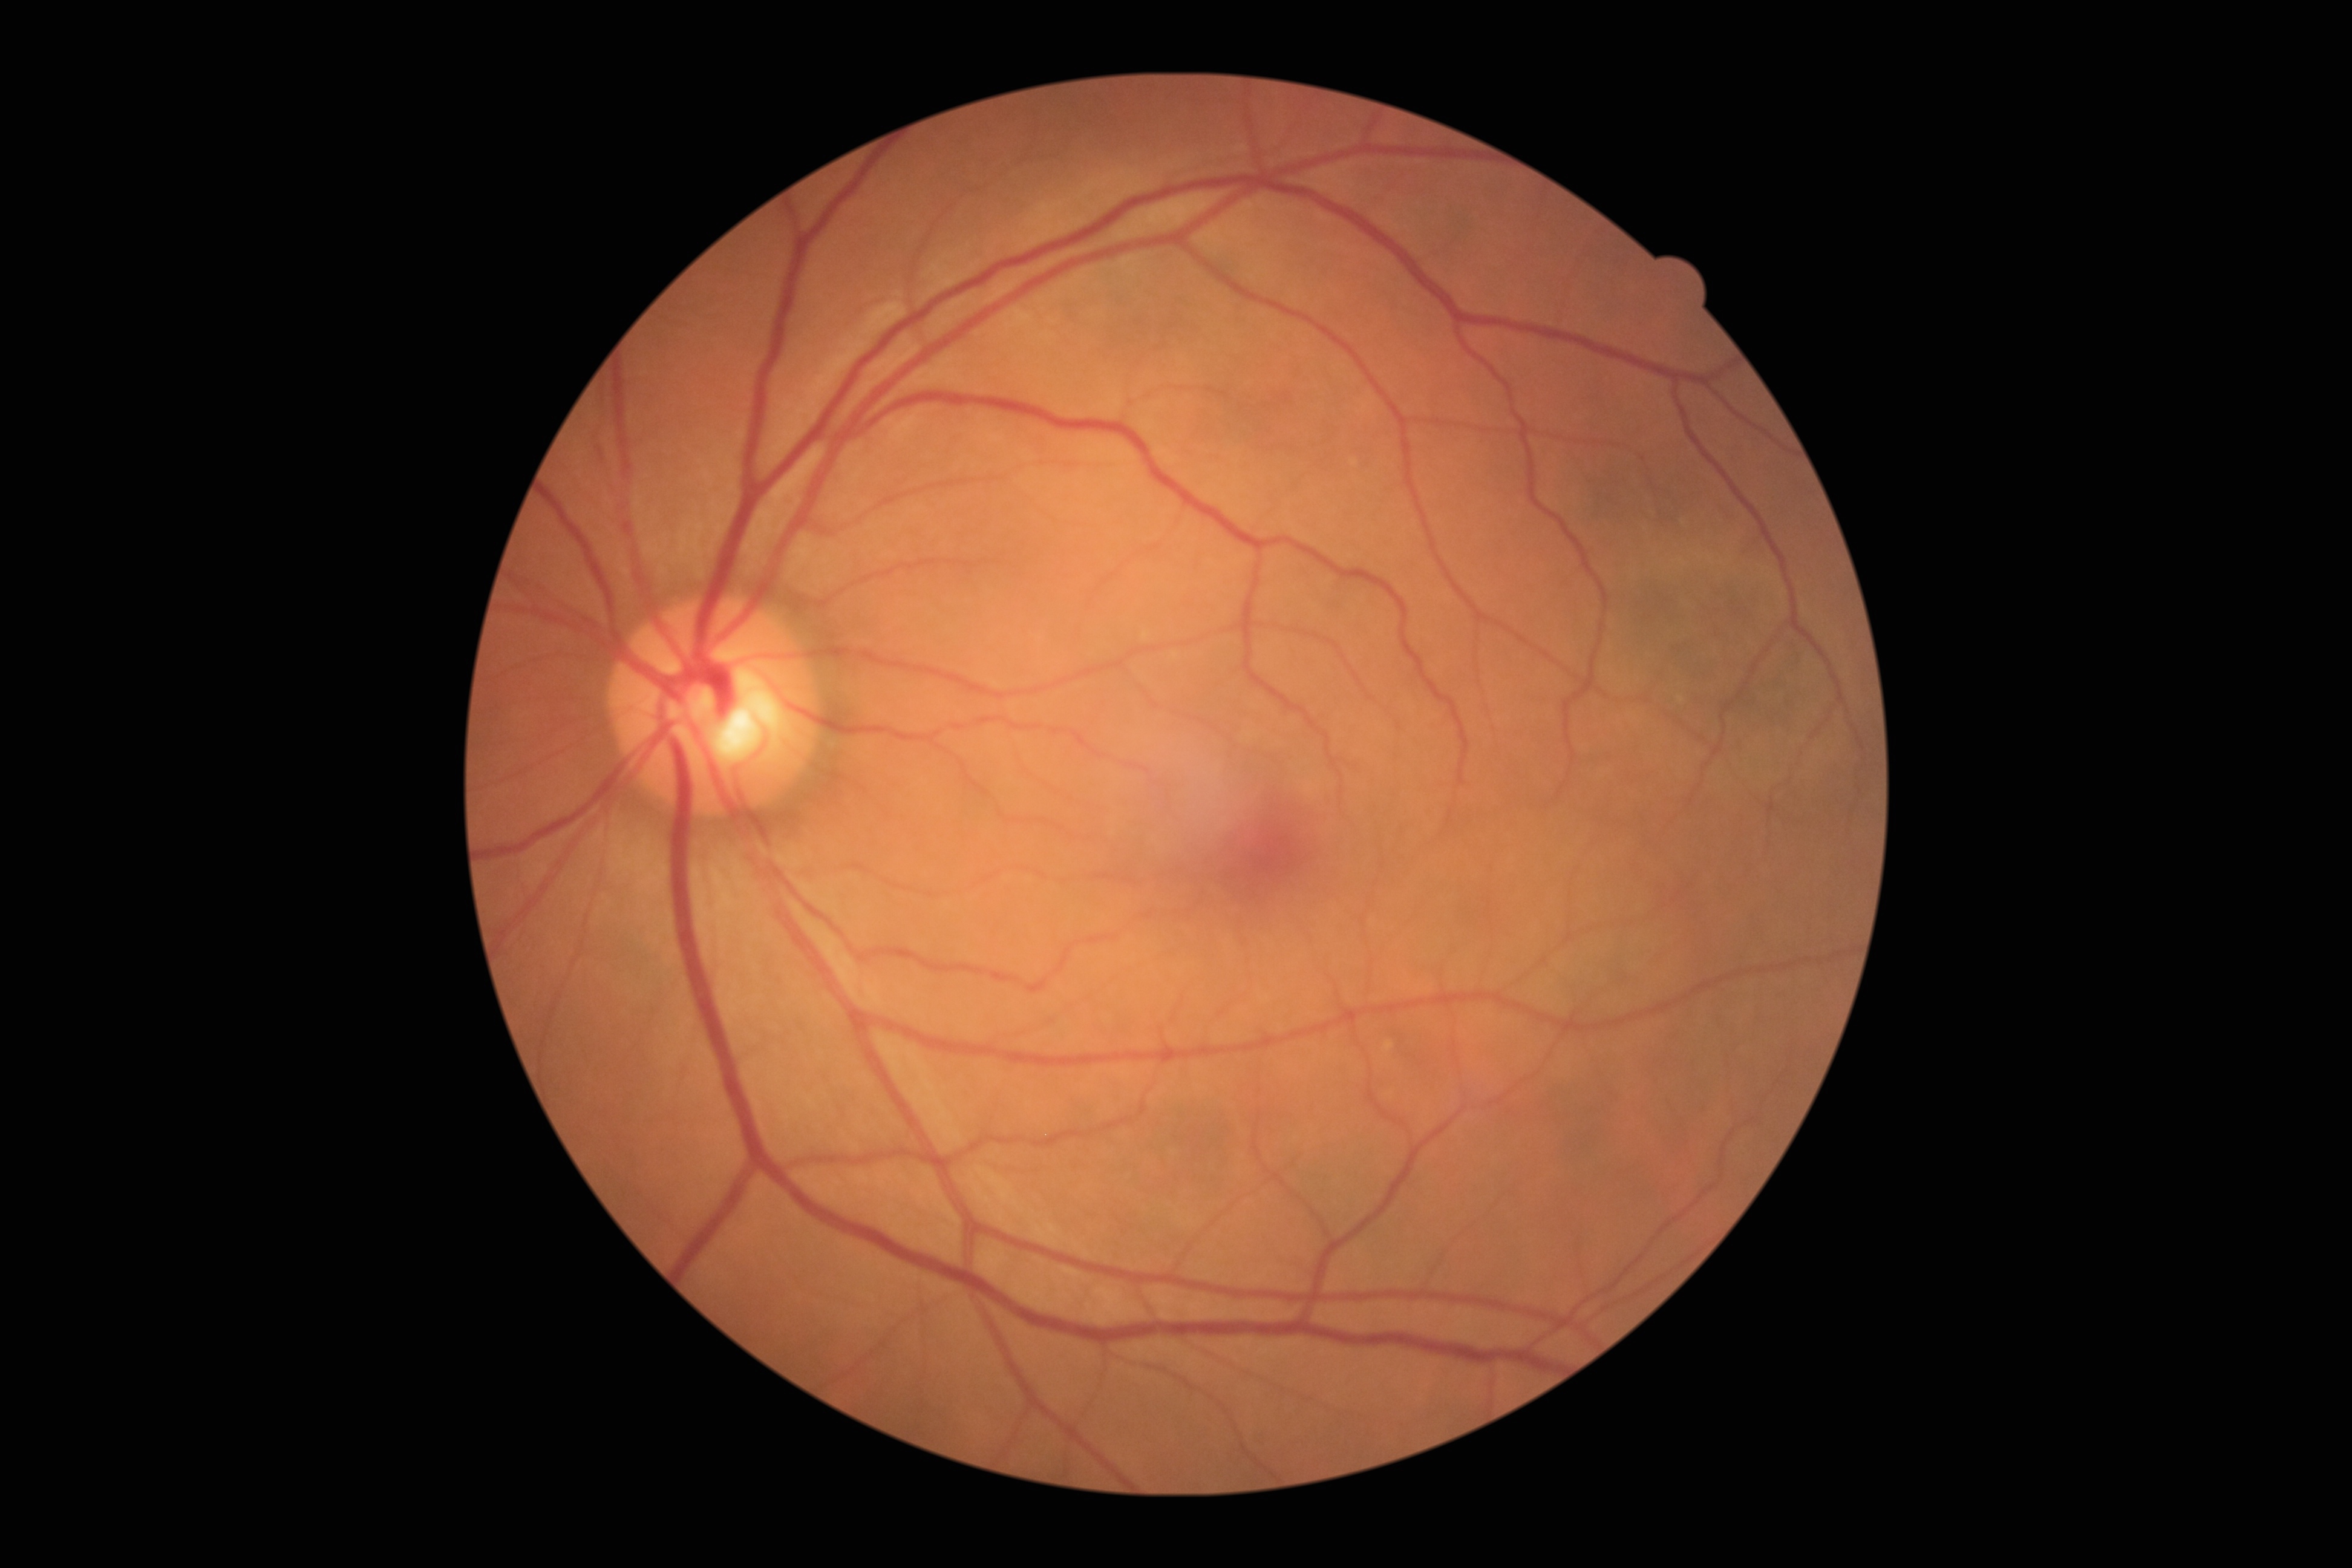
Retinopathy grade: 0 (no apparent retinopathy).
No diabetic retinal disease findings.